848 x 848 pixels.
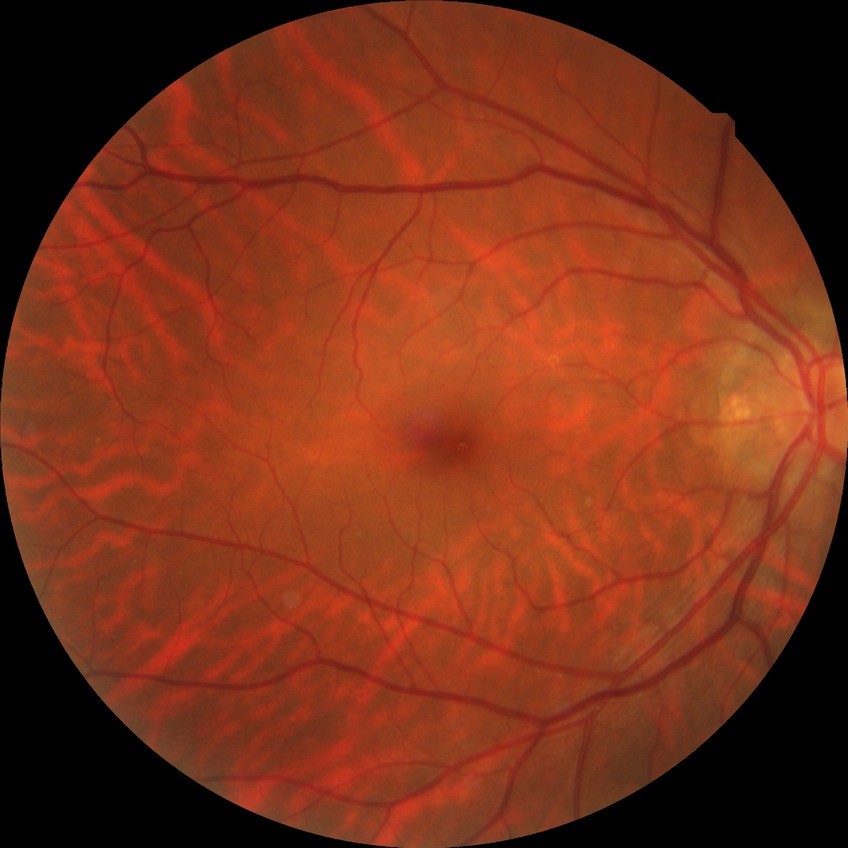

Retinopathy stage is no diabetic retinopathy.